512 by 512 pixels
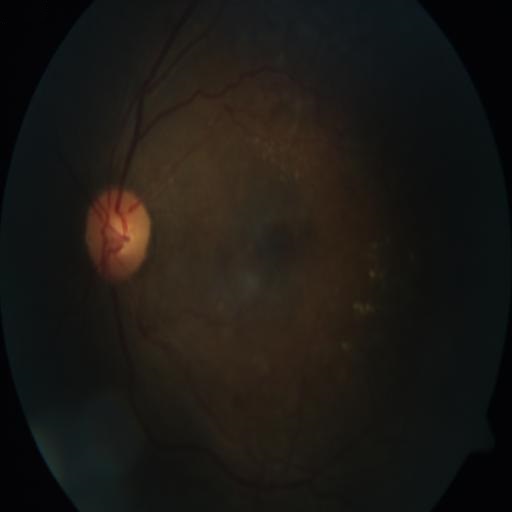 Abnormalities: exudation (EDN) | tortuous vessels (TV).